Color fundus photograph. Image size 848x848. Diabetic retinopathy graded by the modified Davis classification — 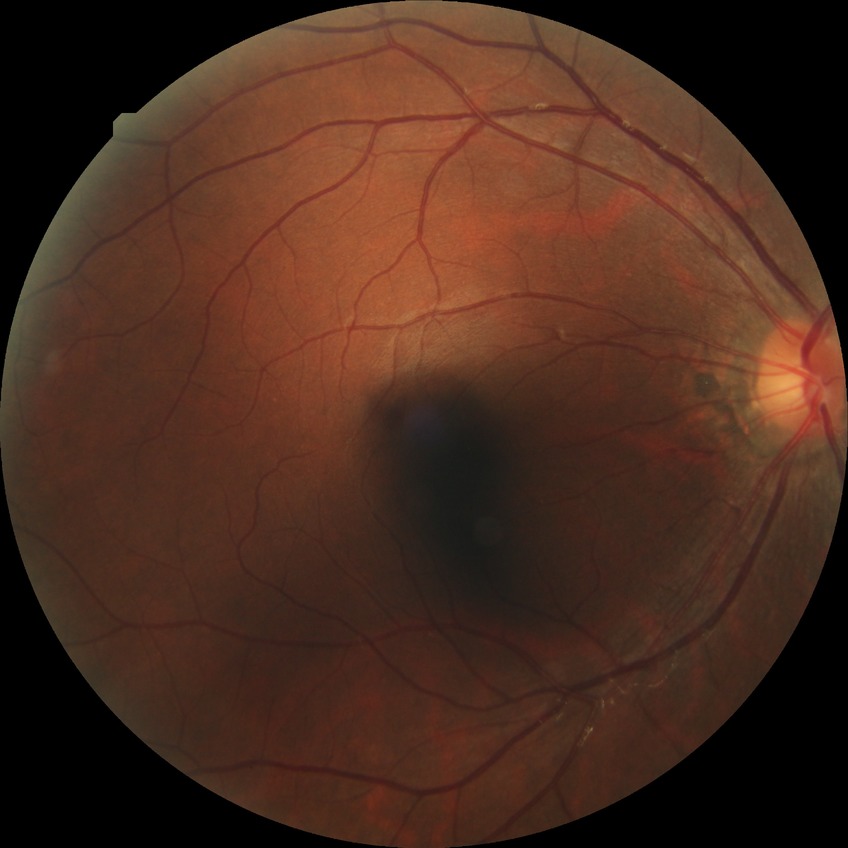
diabetic retinopathy grade = no diabetic retinopathy.